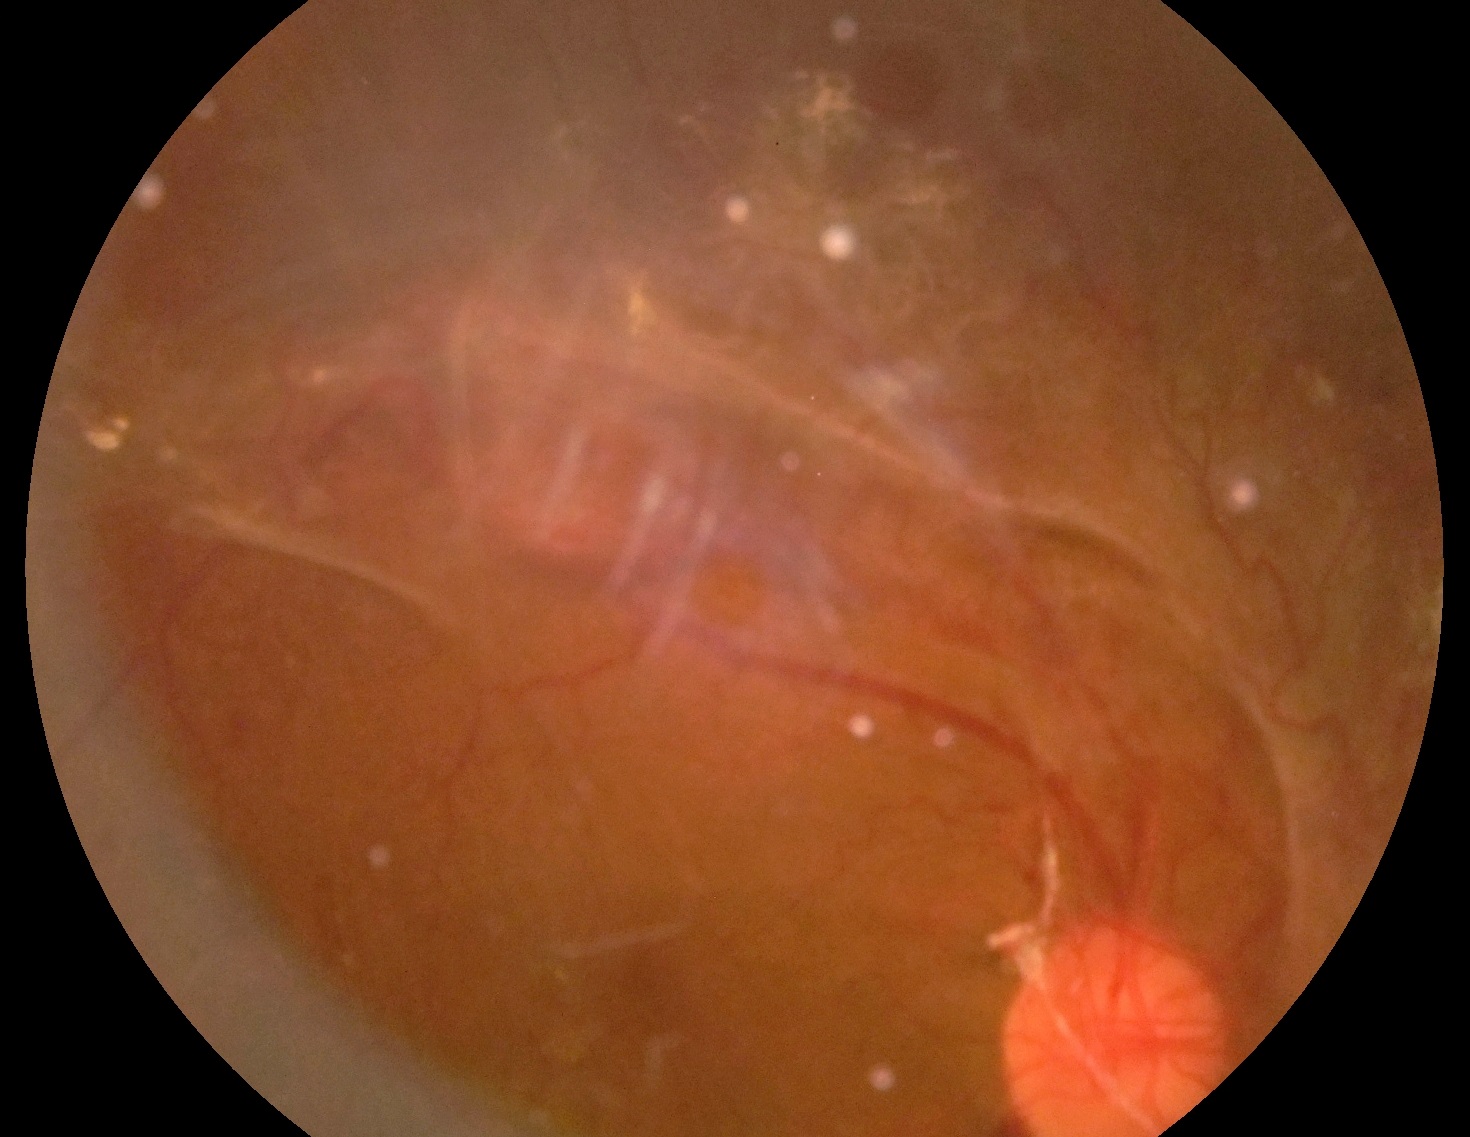 DR class: proliferative diabetic retinopathy. Retinopathy grade is 4 (PDR) — neovascularization and/or vitreous/pre-retinal hemorrhage.